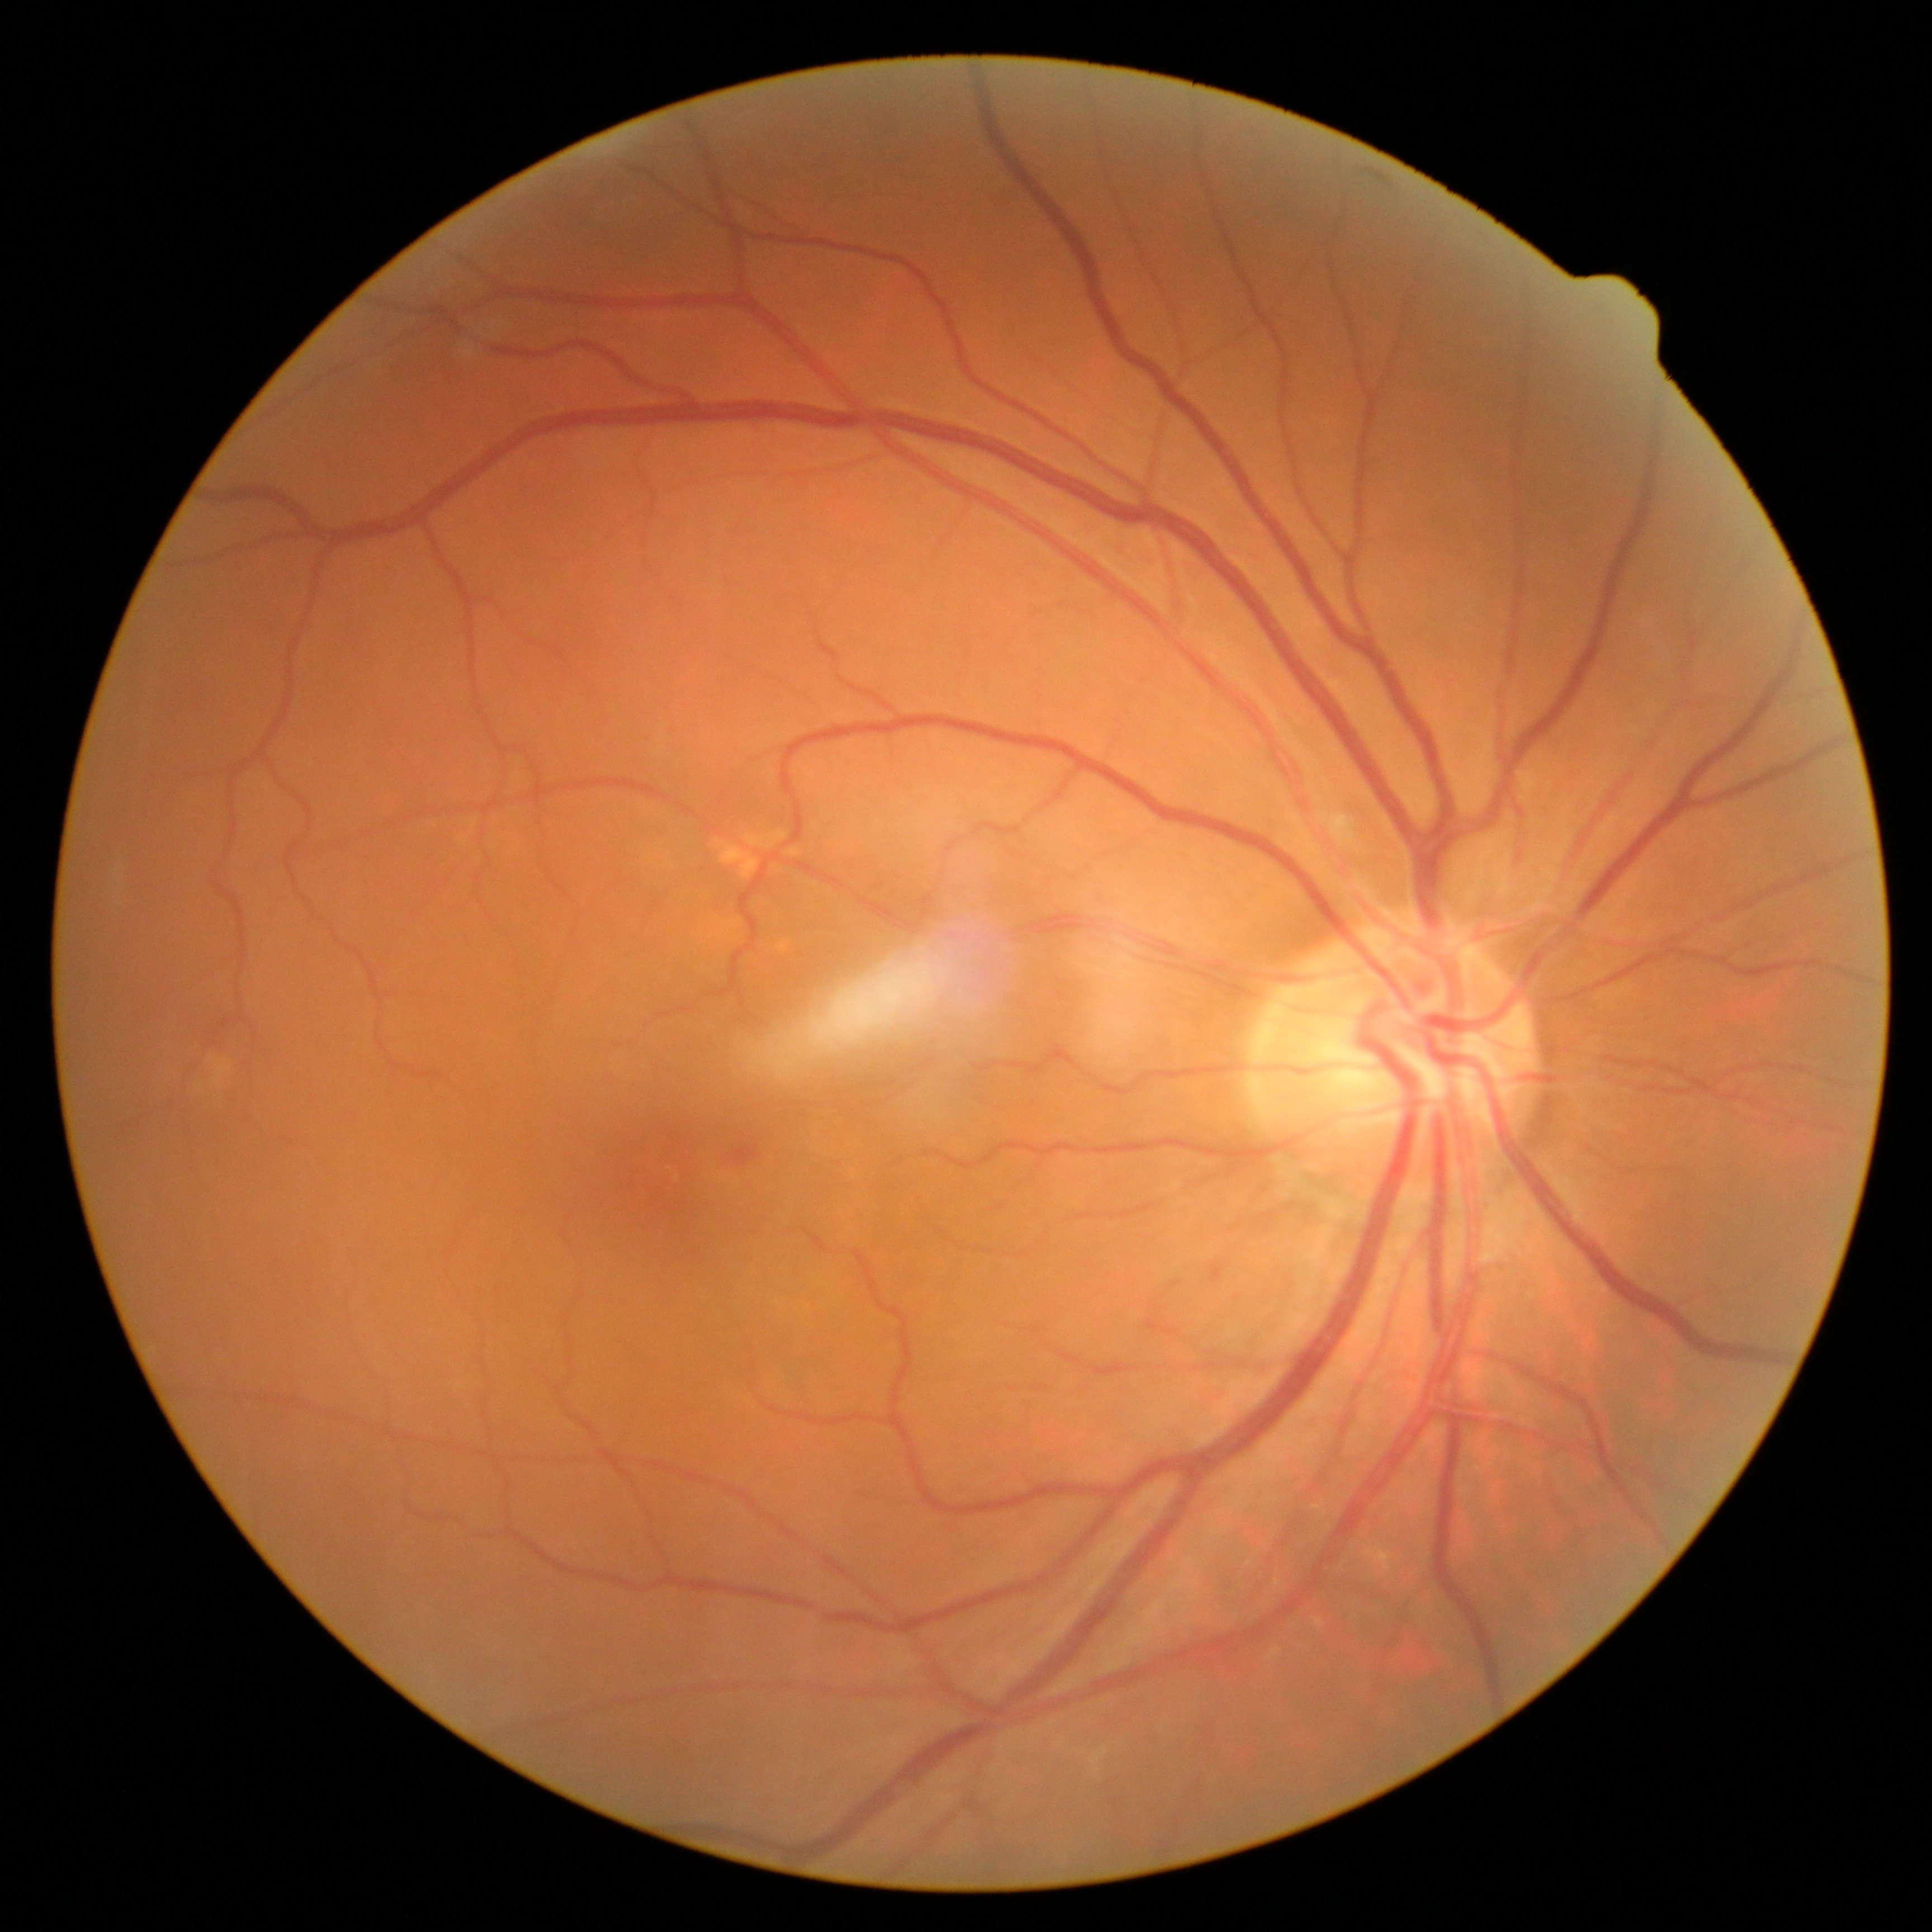 Diabetic retinopathy (DR): 2.